Captured on a Remidio Fundus on Phone · color fundus image · 1659 by 2212 pixels — 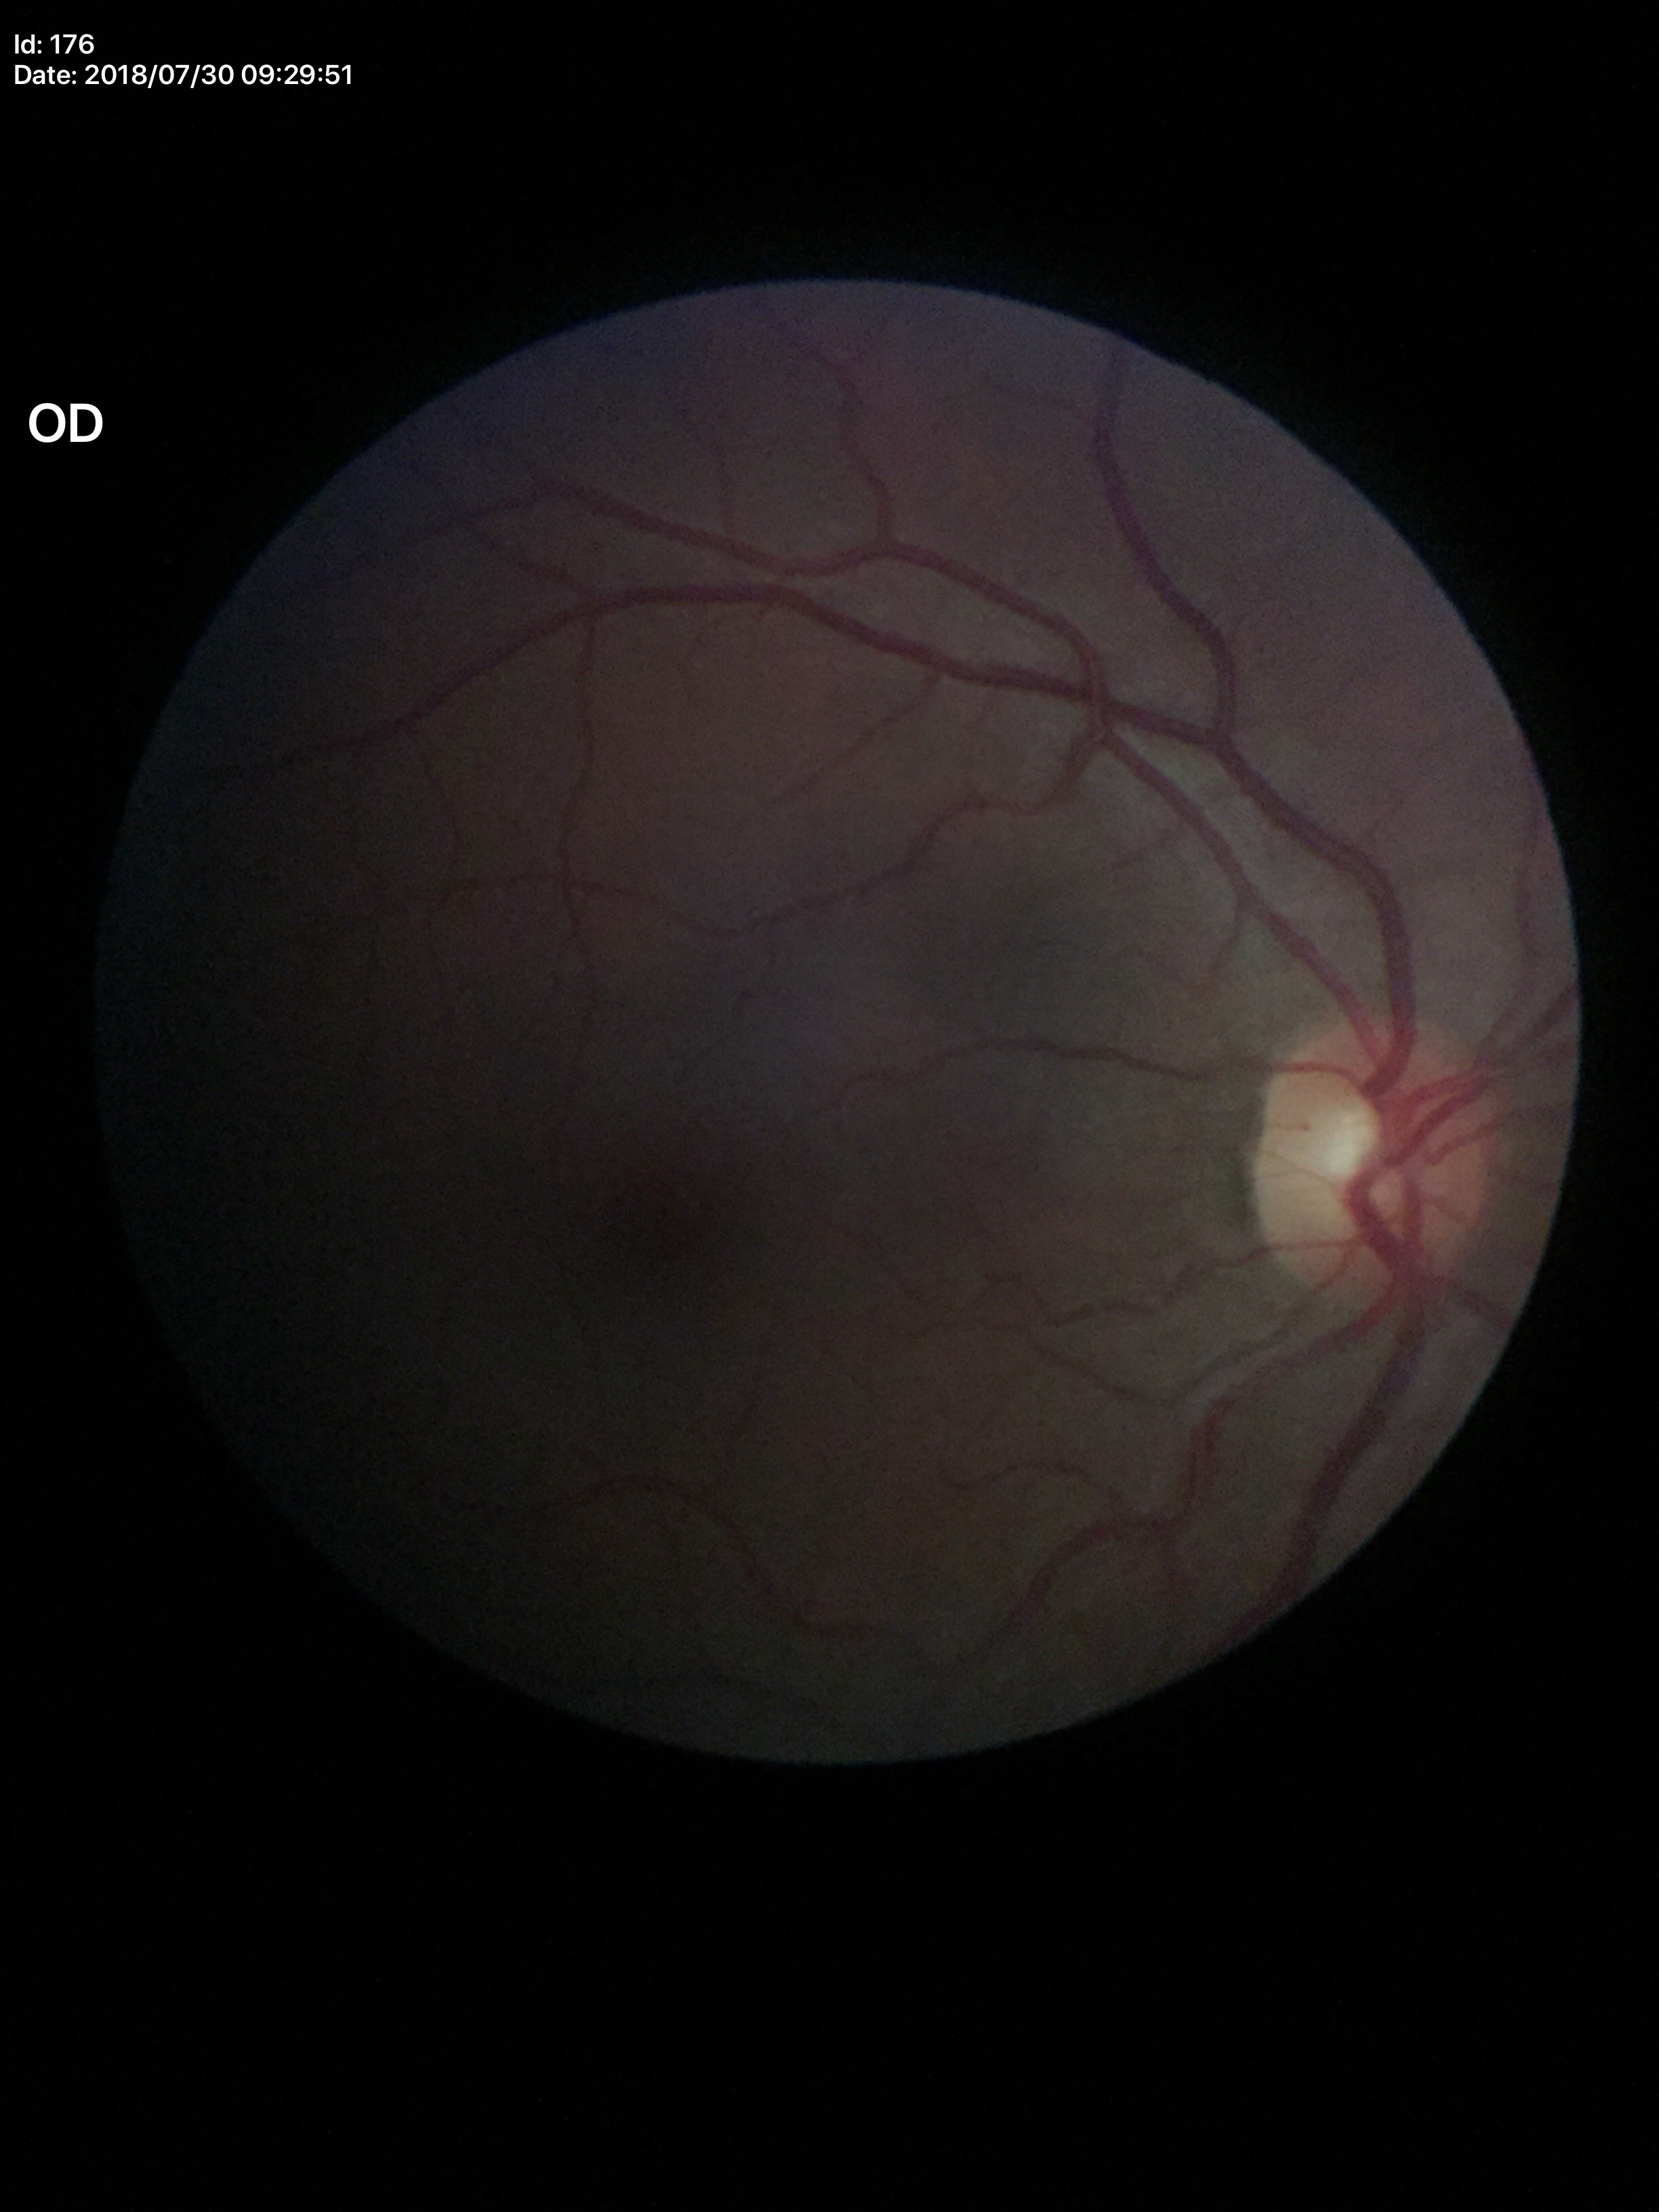

Glaucoma screening impression: not suspect; vertical cup-to-disc ratio: 0.50; area CDR: 0.25; horizontal cup-to-disc ratio: 0.51